UWF retinal mosaic · 1924 x 1556 pixels · FOV: 200 degrees
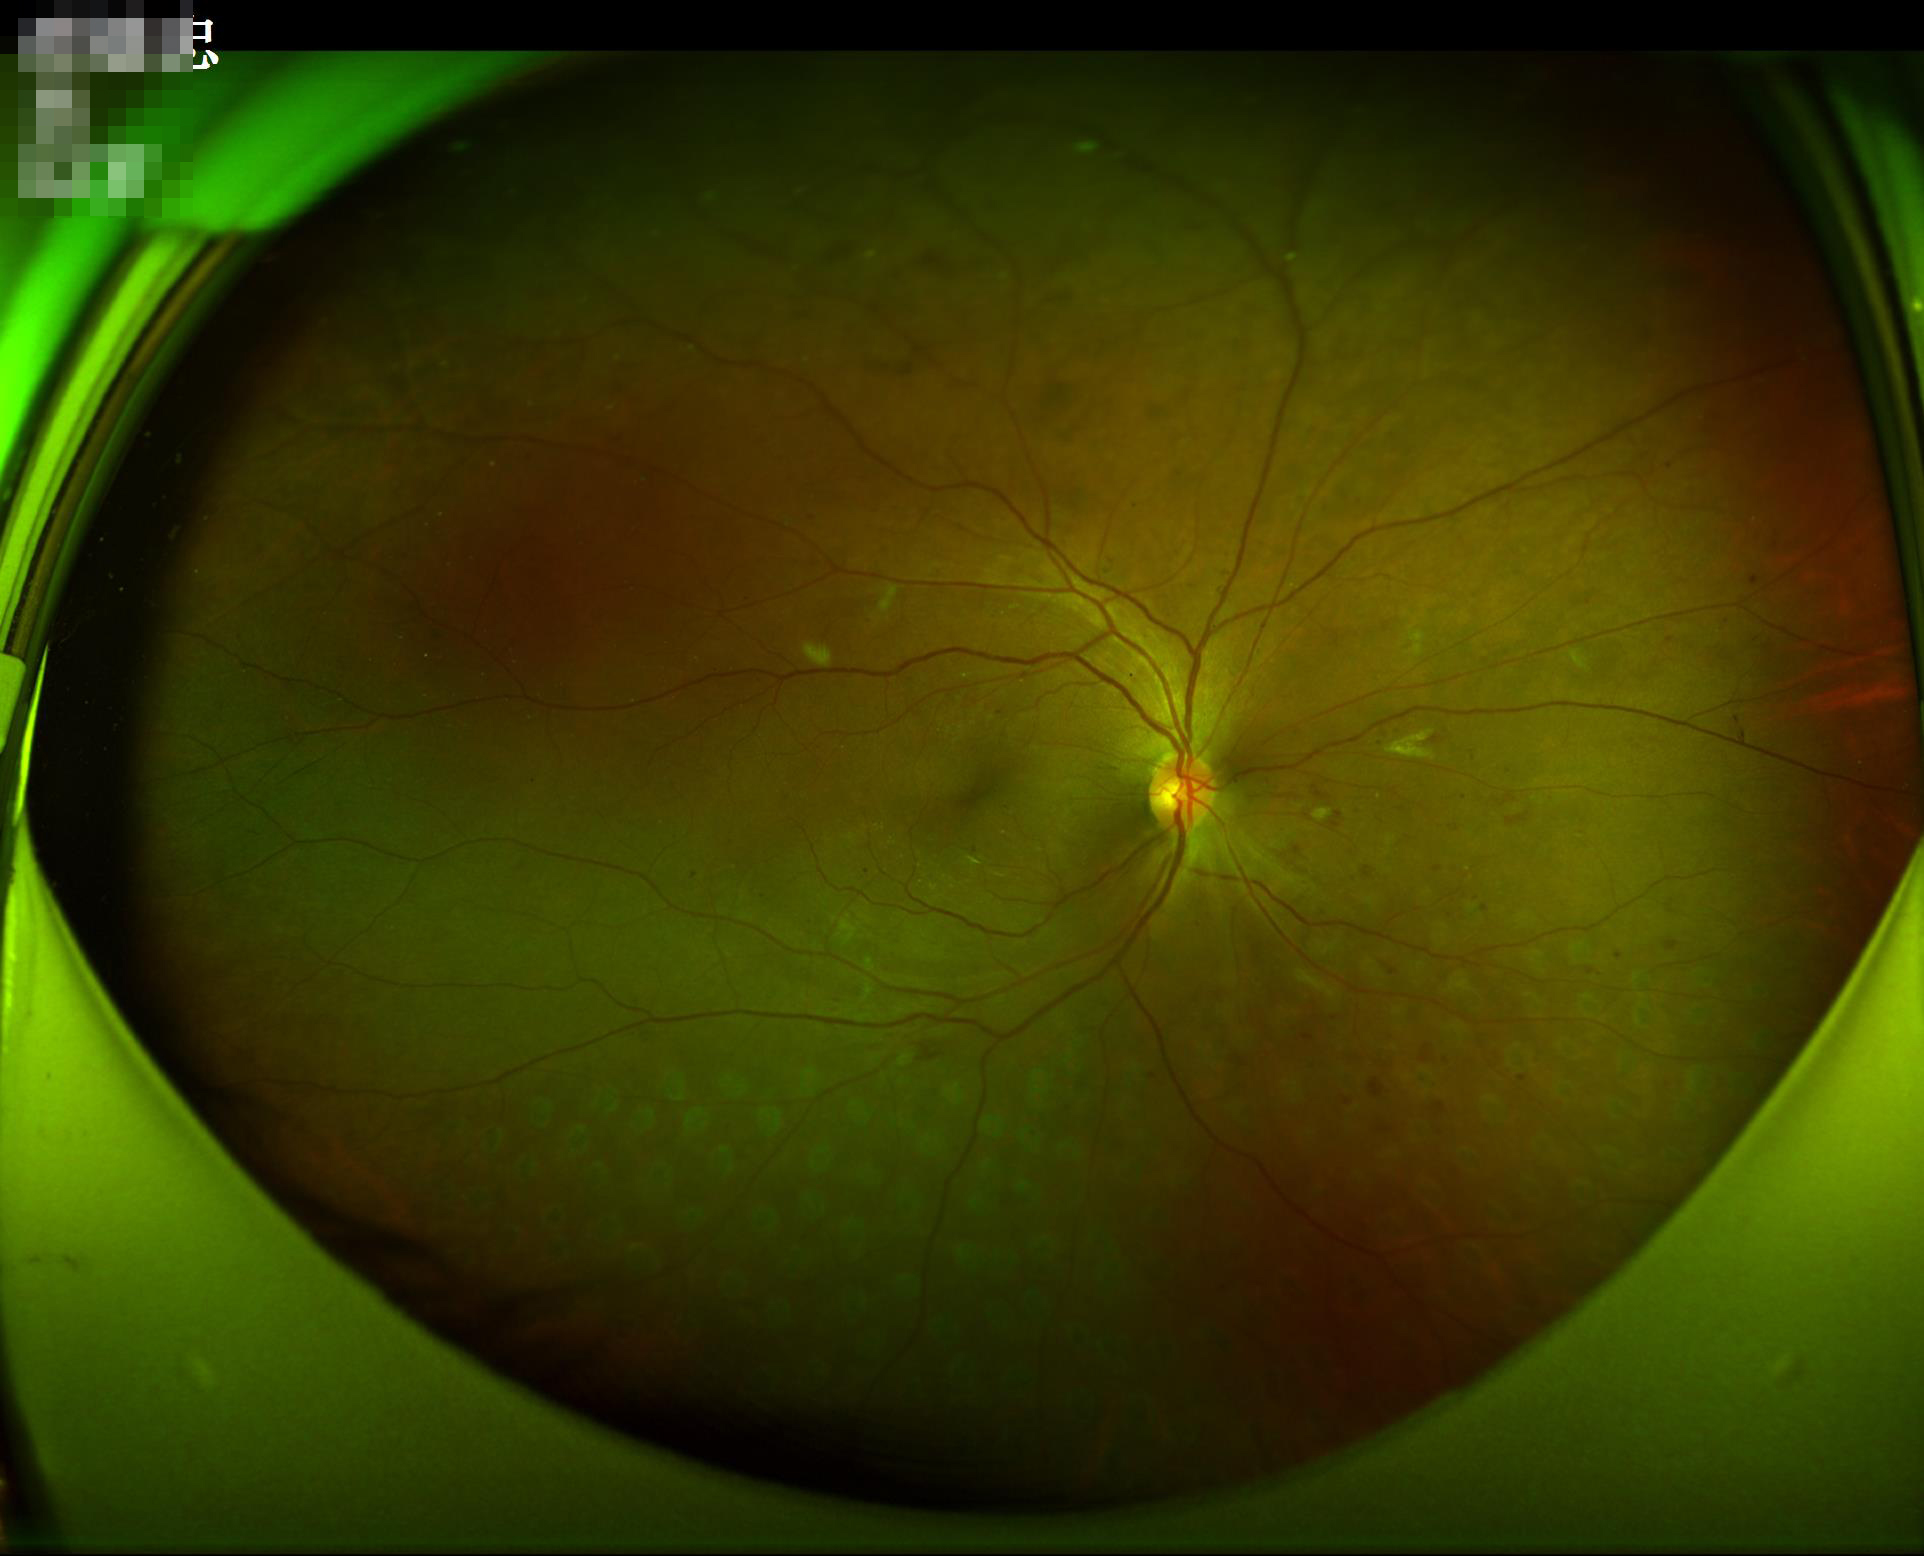 Image quality: contrast: adequate | overall: acceptable | illumination: adequate | sharpness: clear.